Color fundus photograph
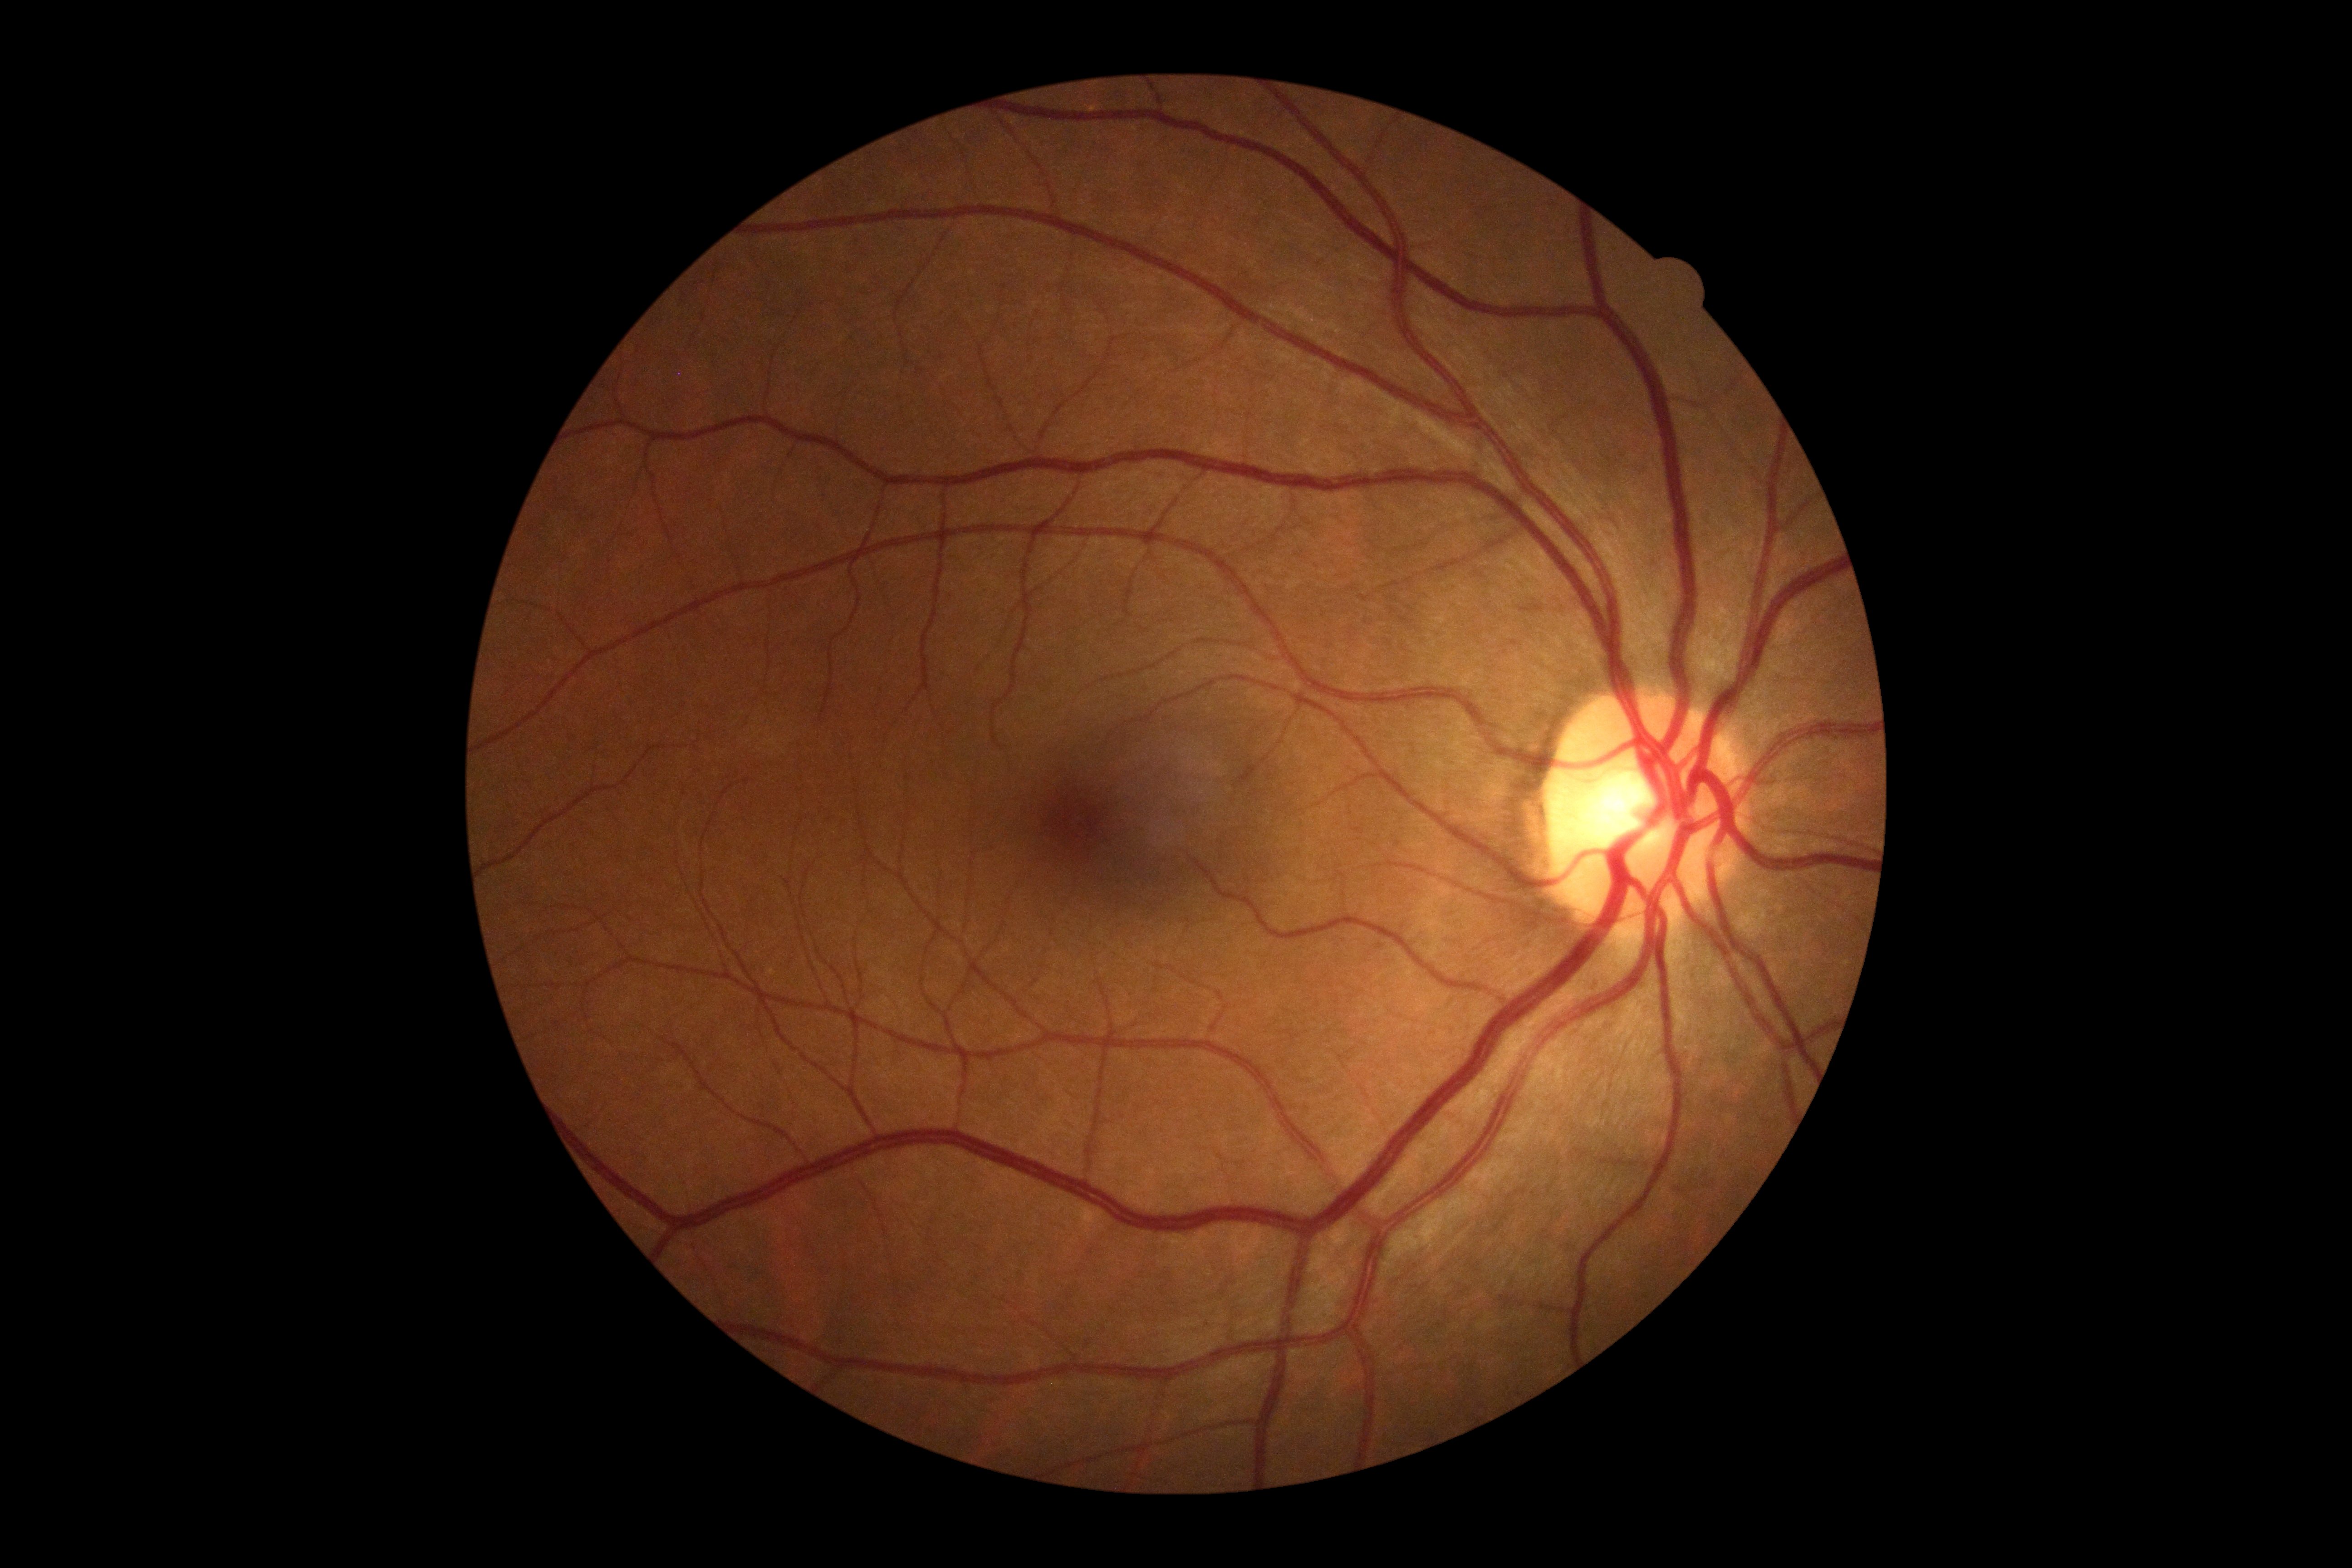

Annotations:
• DR impression: no DR findings
• diabetic retinopathy grade: no apparent retinopathy (0)